FOV: 45 degrees — 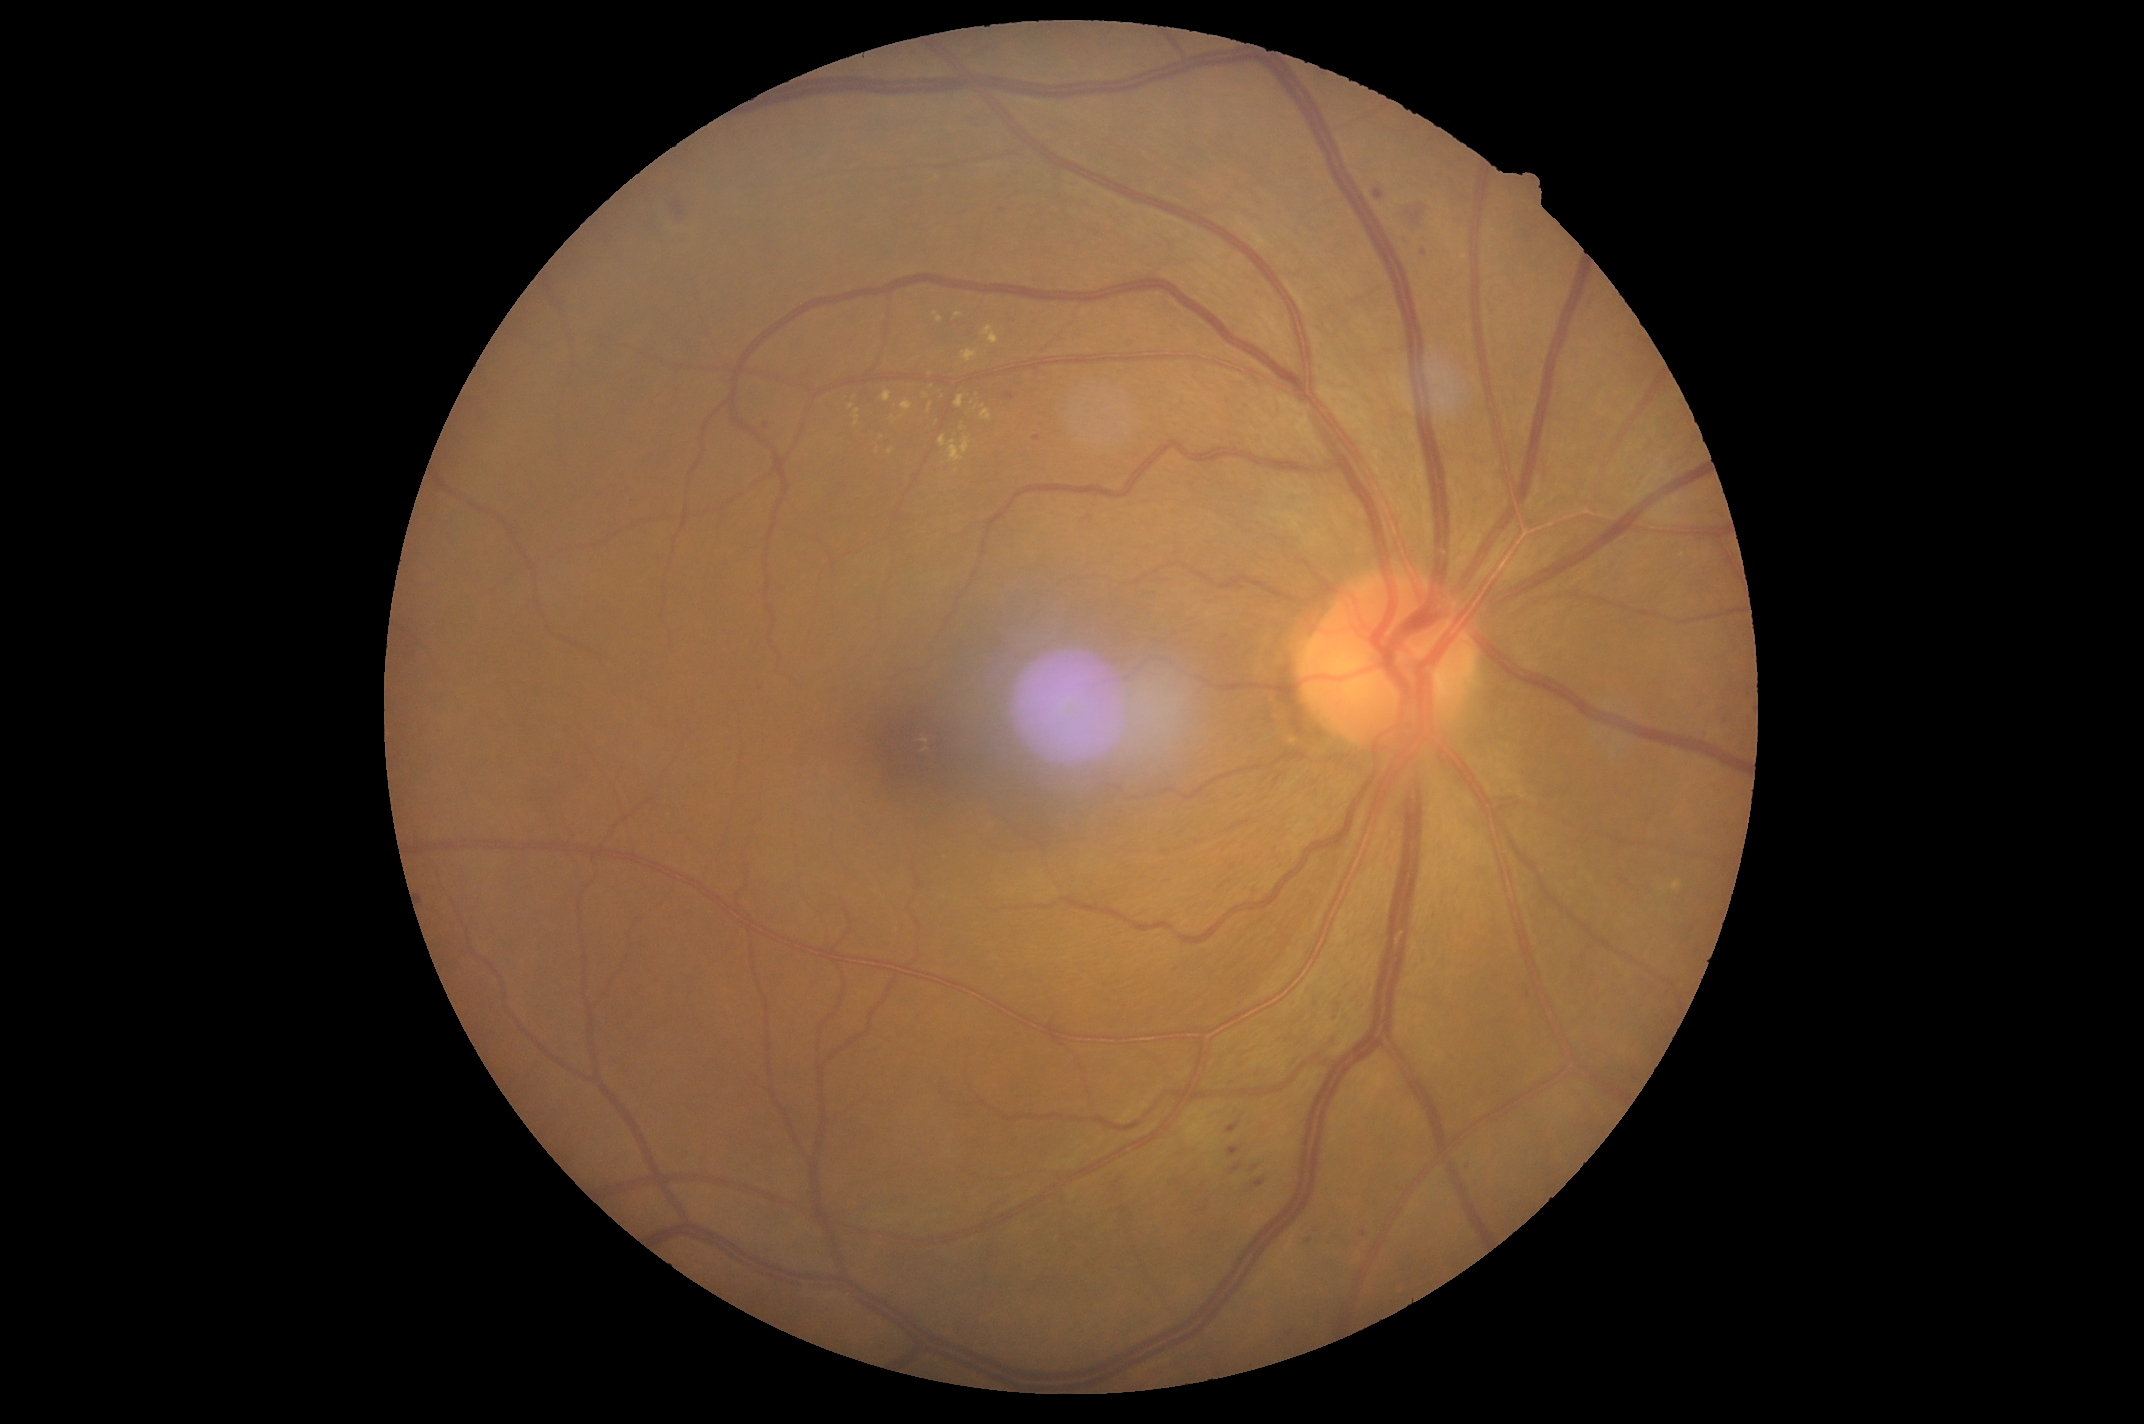

DR class: non-proliferative diabetic retinopathy. Retinopathy grade is moderate non-proliferative diabetic retinopathy (2).